NIDEK AFC-230 fundus camera; 848x848; color fundus photograph; FOV: 45 degrees; nonmydriatic.
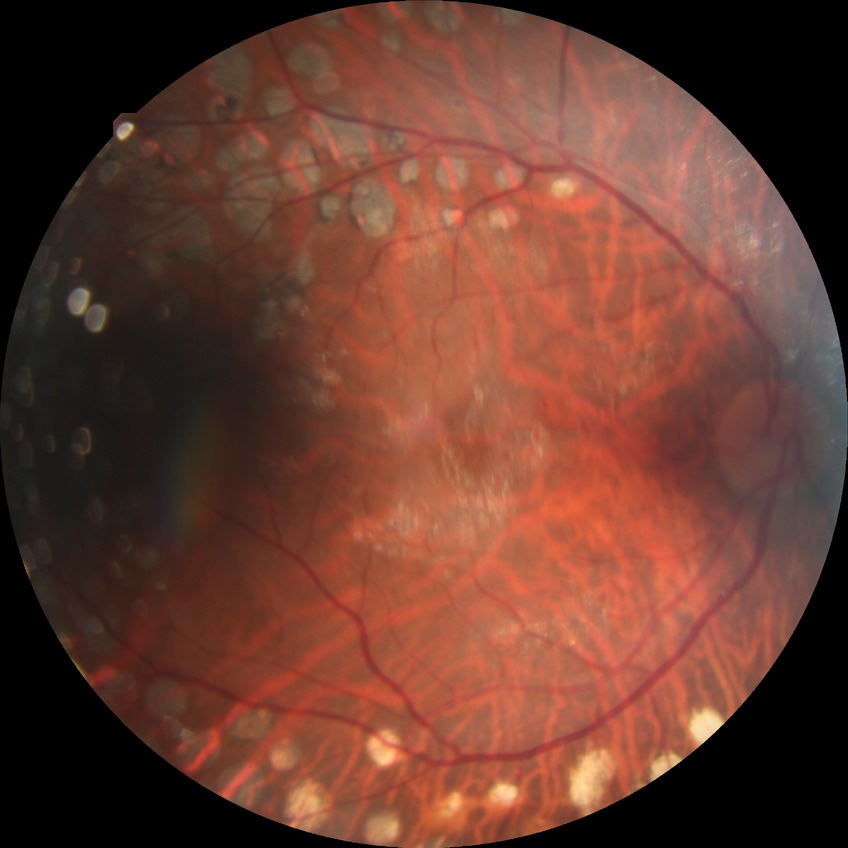 Diabetic retinopathy severity is proliferative diabetic retinopathy.